FOV: 45 degrees: 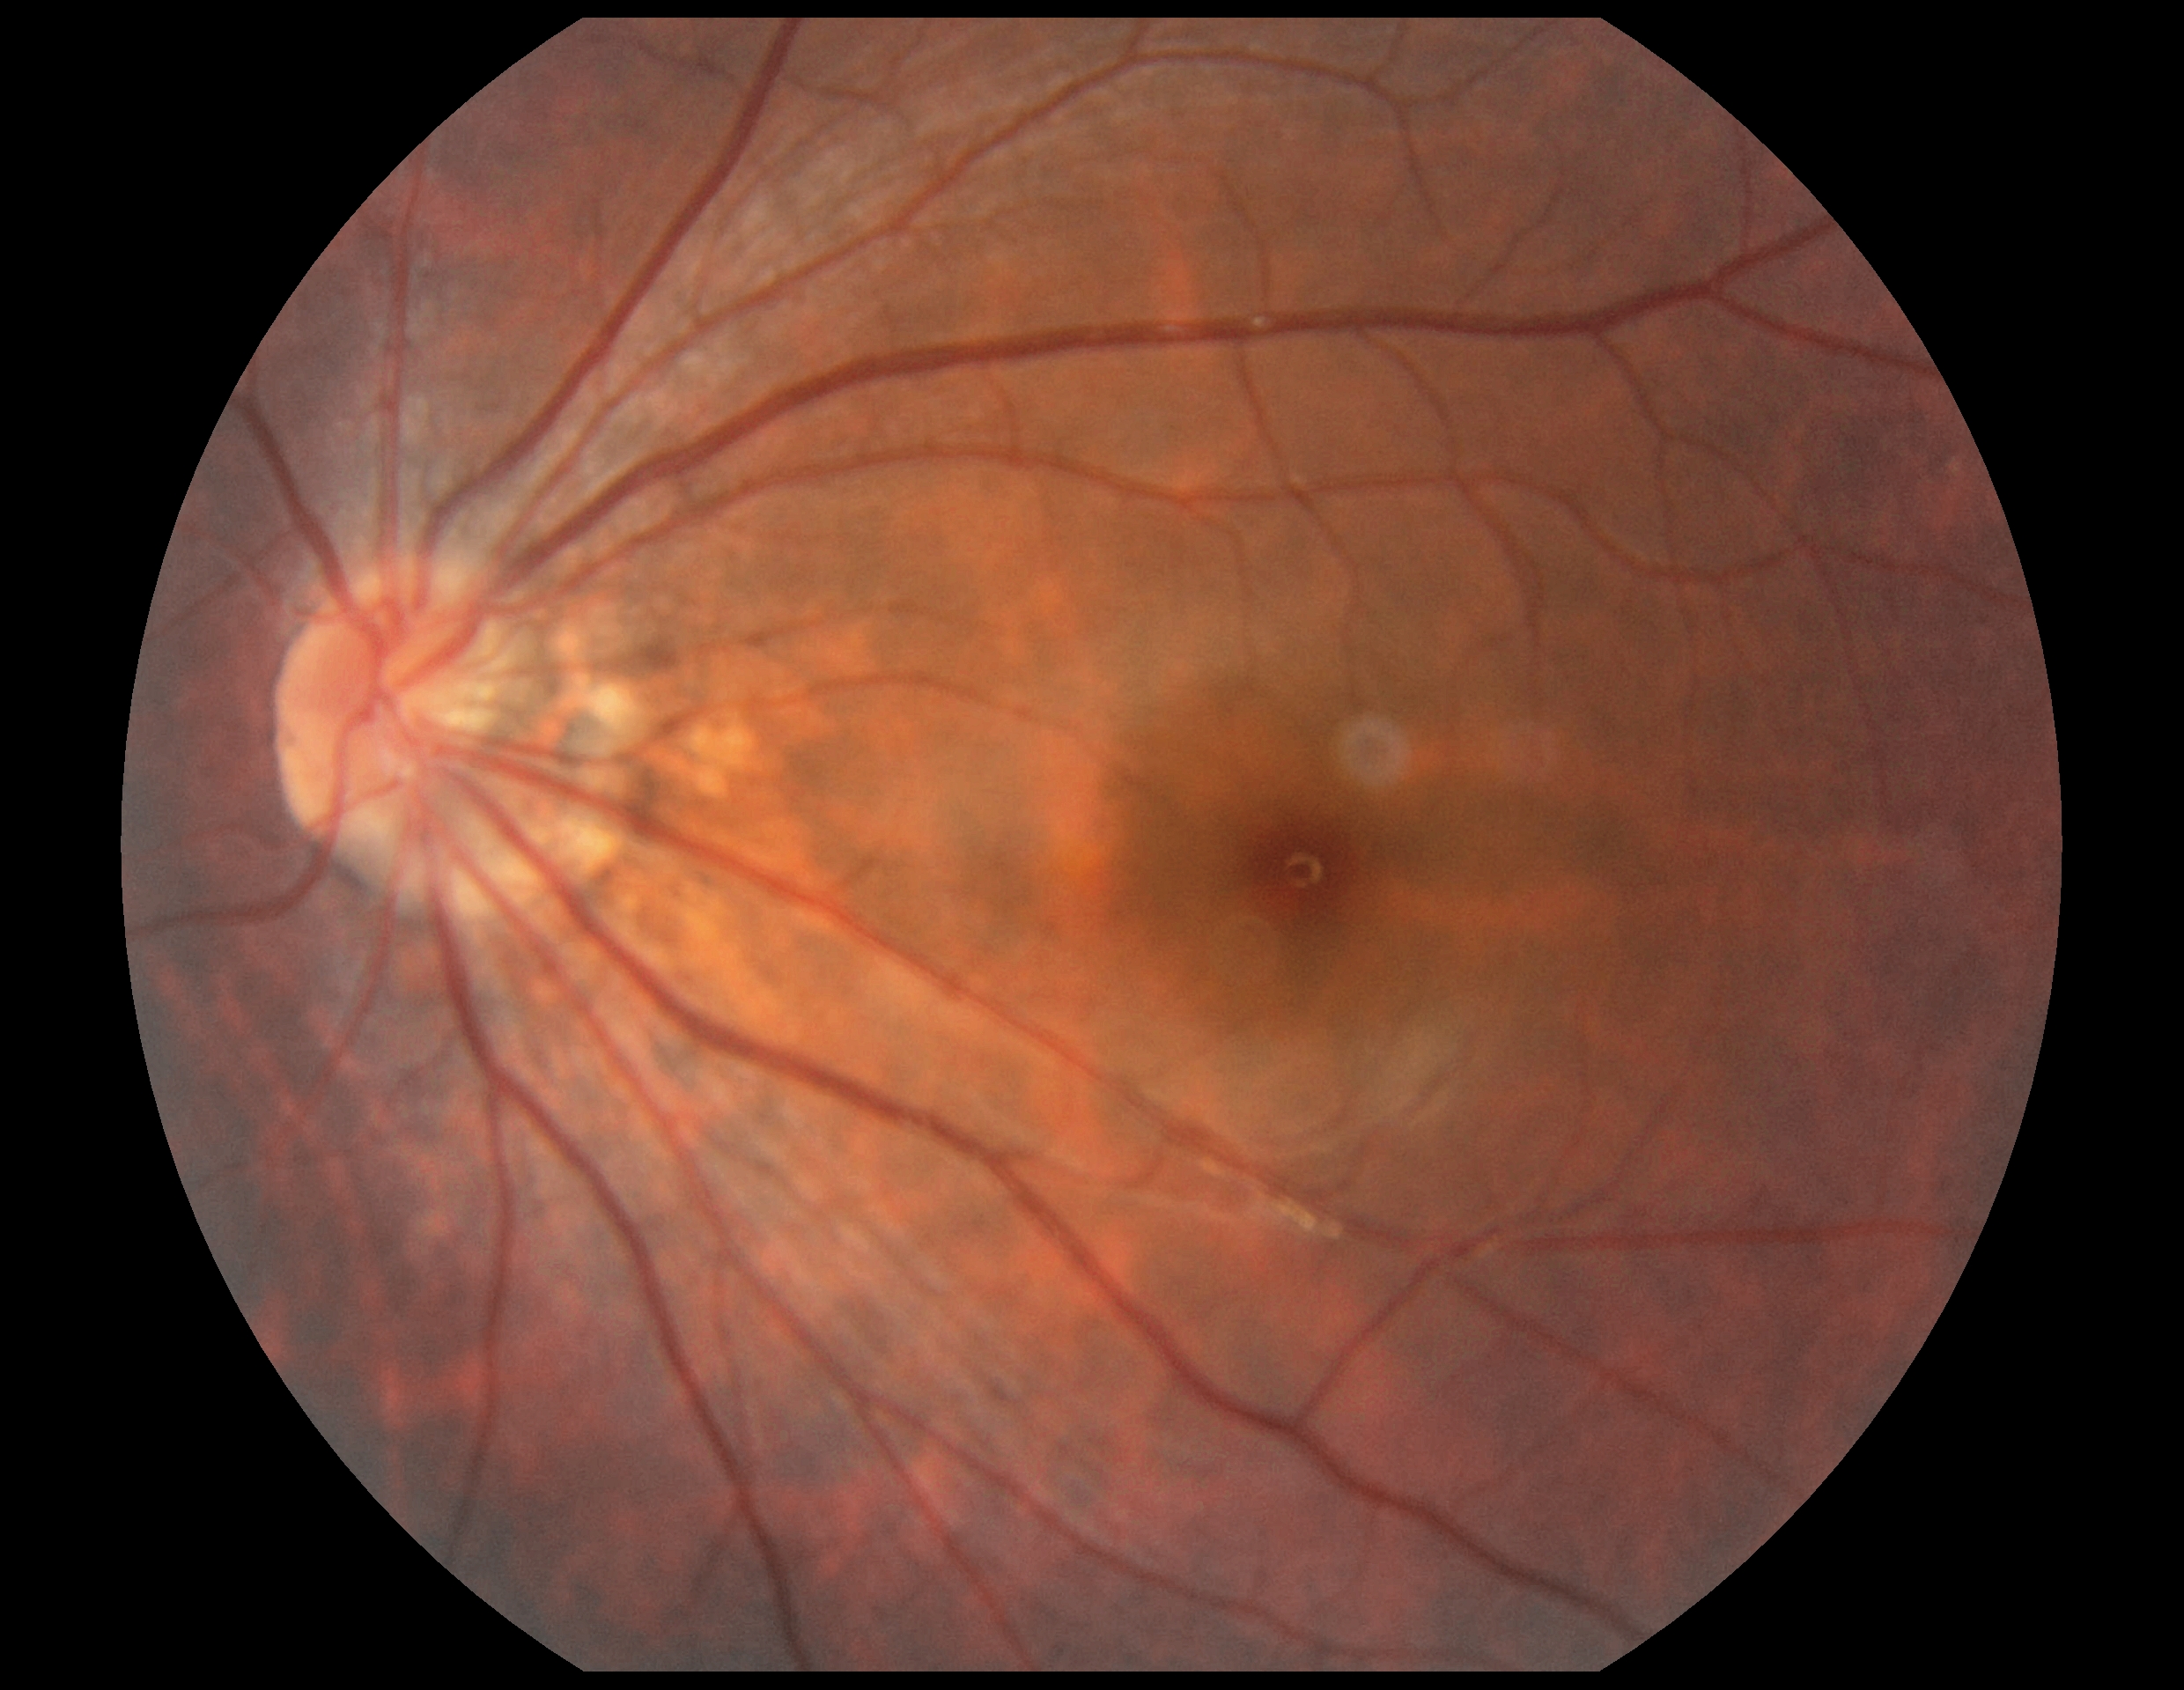
– DR impression: no DR findings
– DR grade: 0/4